Mydriatic, optic disc photograph
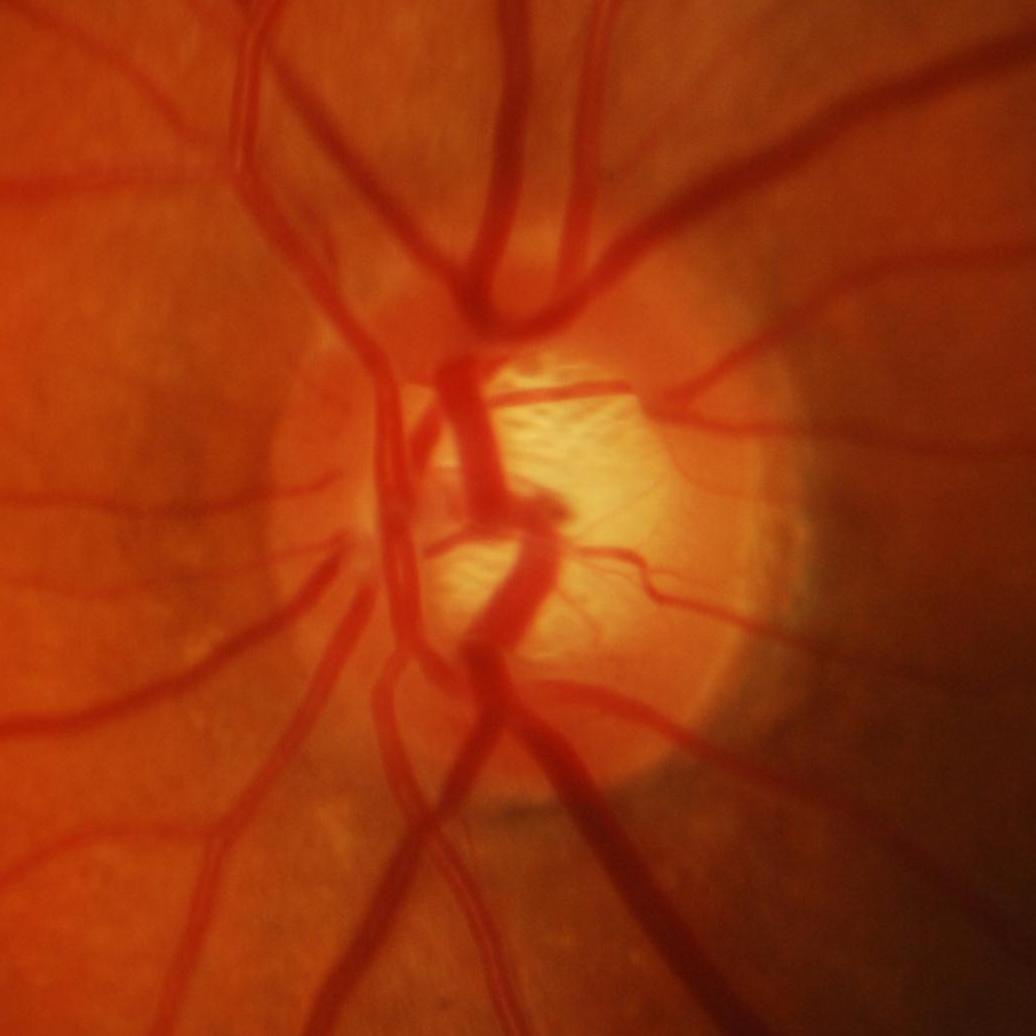
Demonstrates glaucomatous findings.